848x848. Color fundus image:
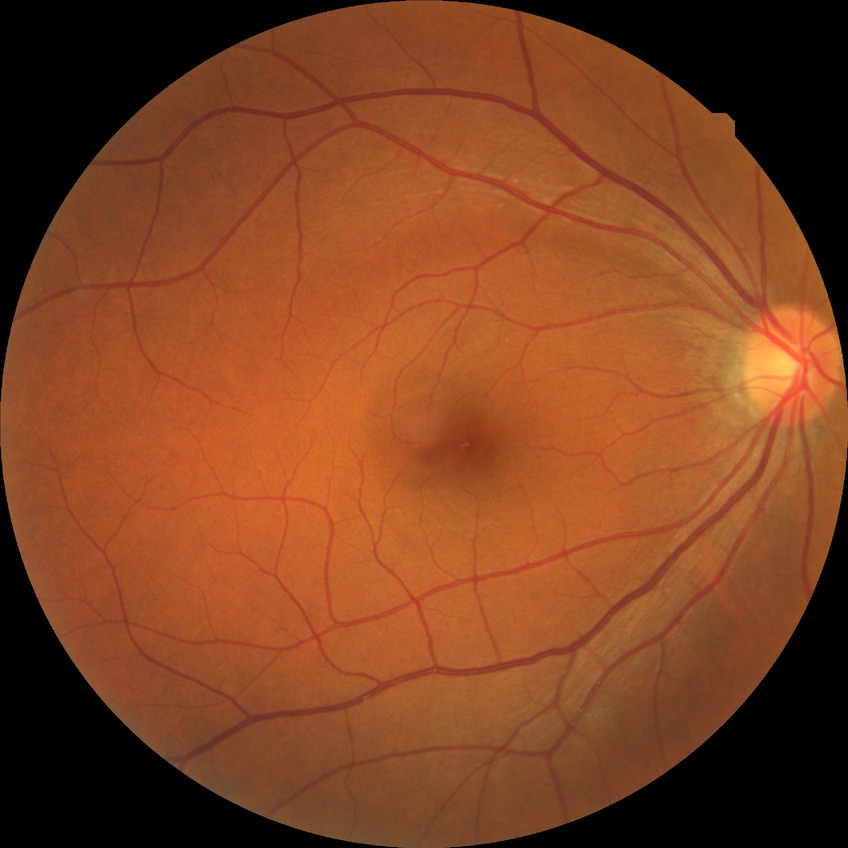
{
  "davis_grade": "NDR (no diabetic retinopathy)"
}